50° field of view:
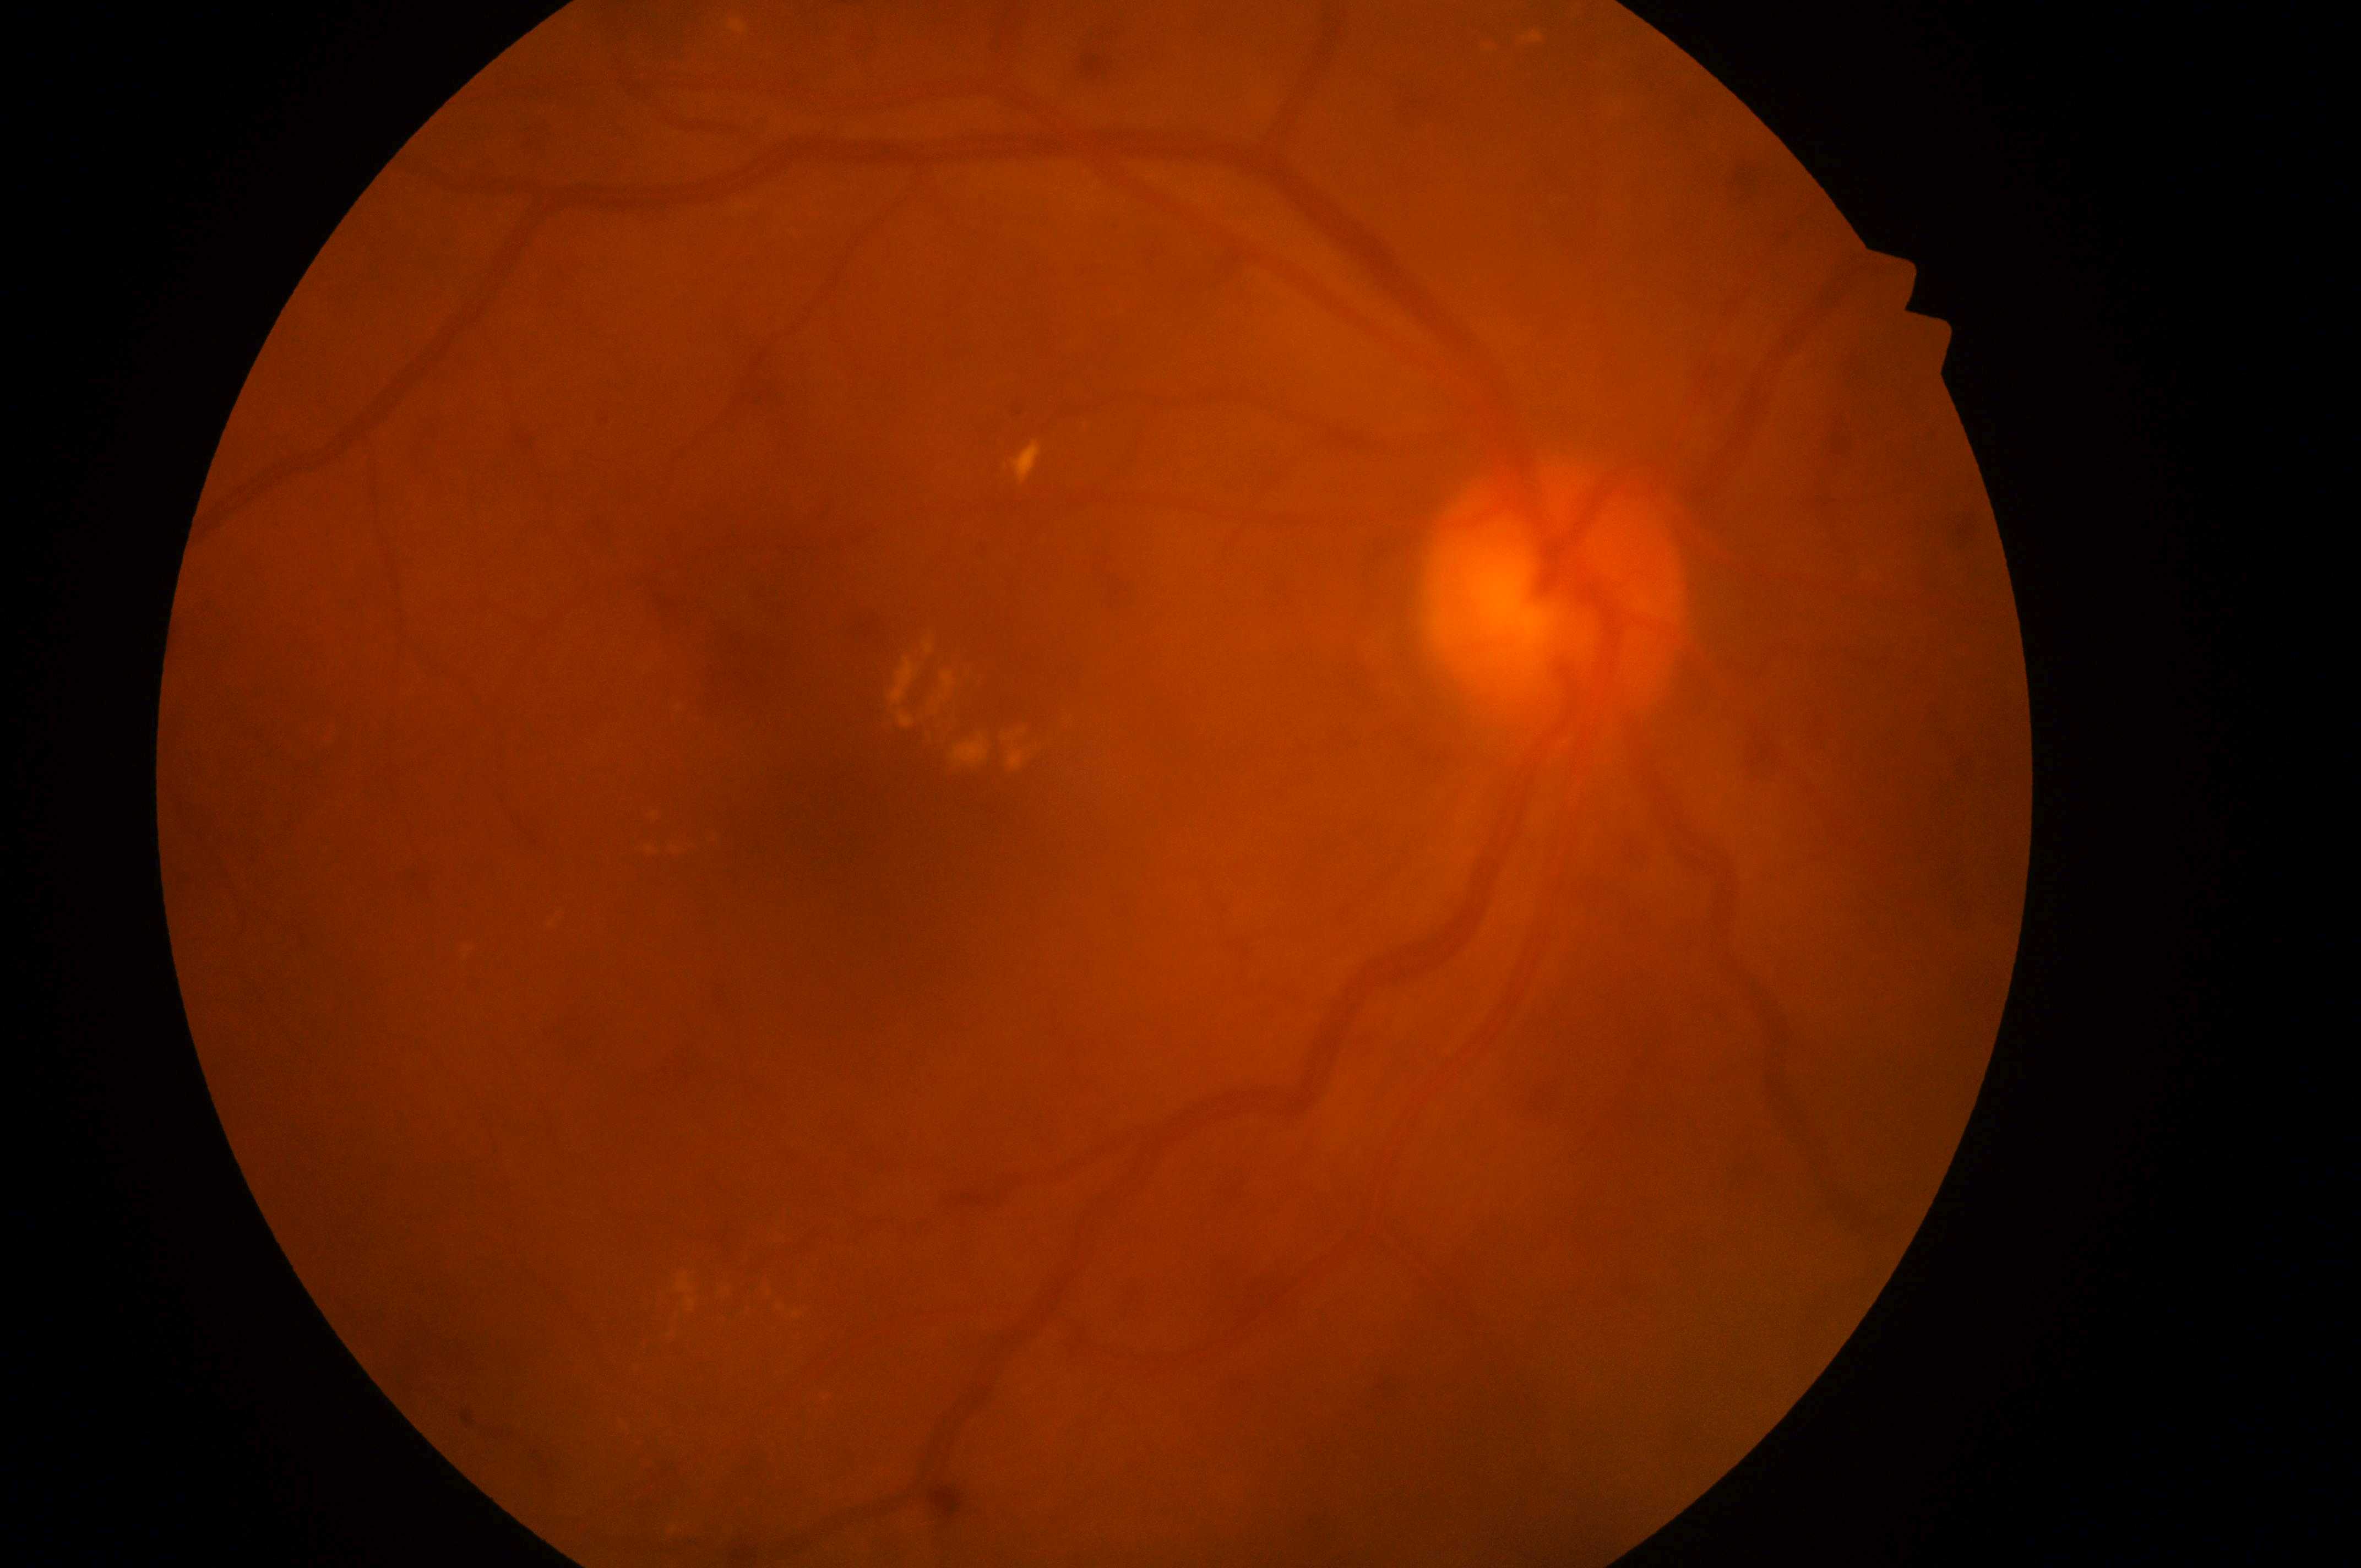 Disc center: (1562,594). Diabetic macular edema (DME) is grade 2 (high risk) — hard exudates within one disc diameter of the macula center. Imaged eye: oculus dexter. Foveal center located at (837,823). Diabetic retinopathy (DR) is moderate NPDR (grade 2) — more than just microaneurysms but less than severe NPDR.